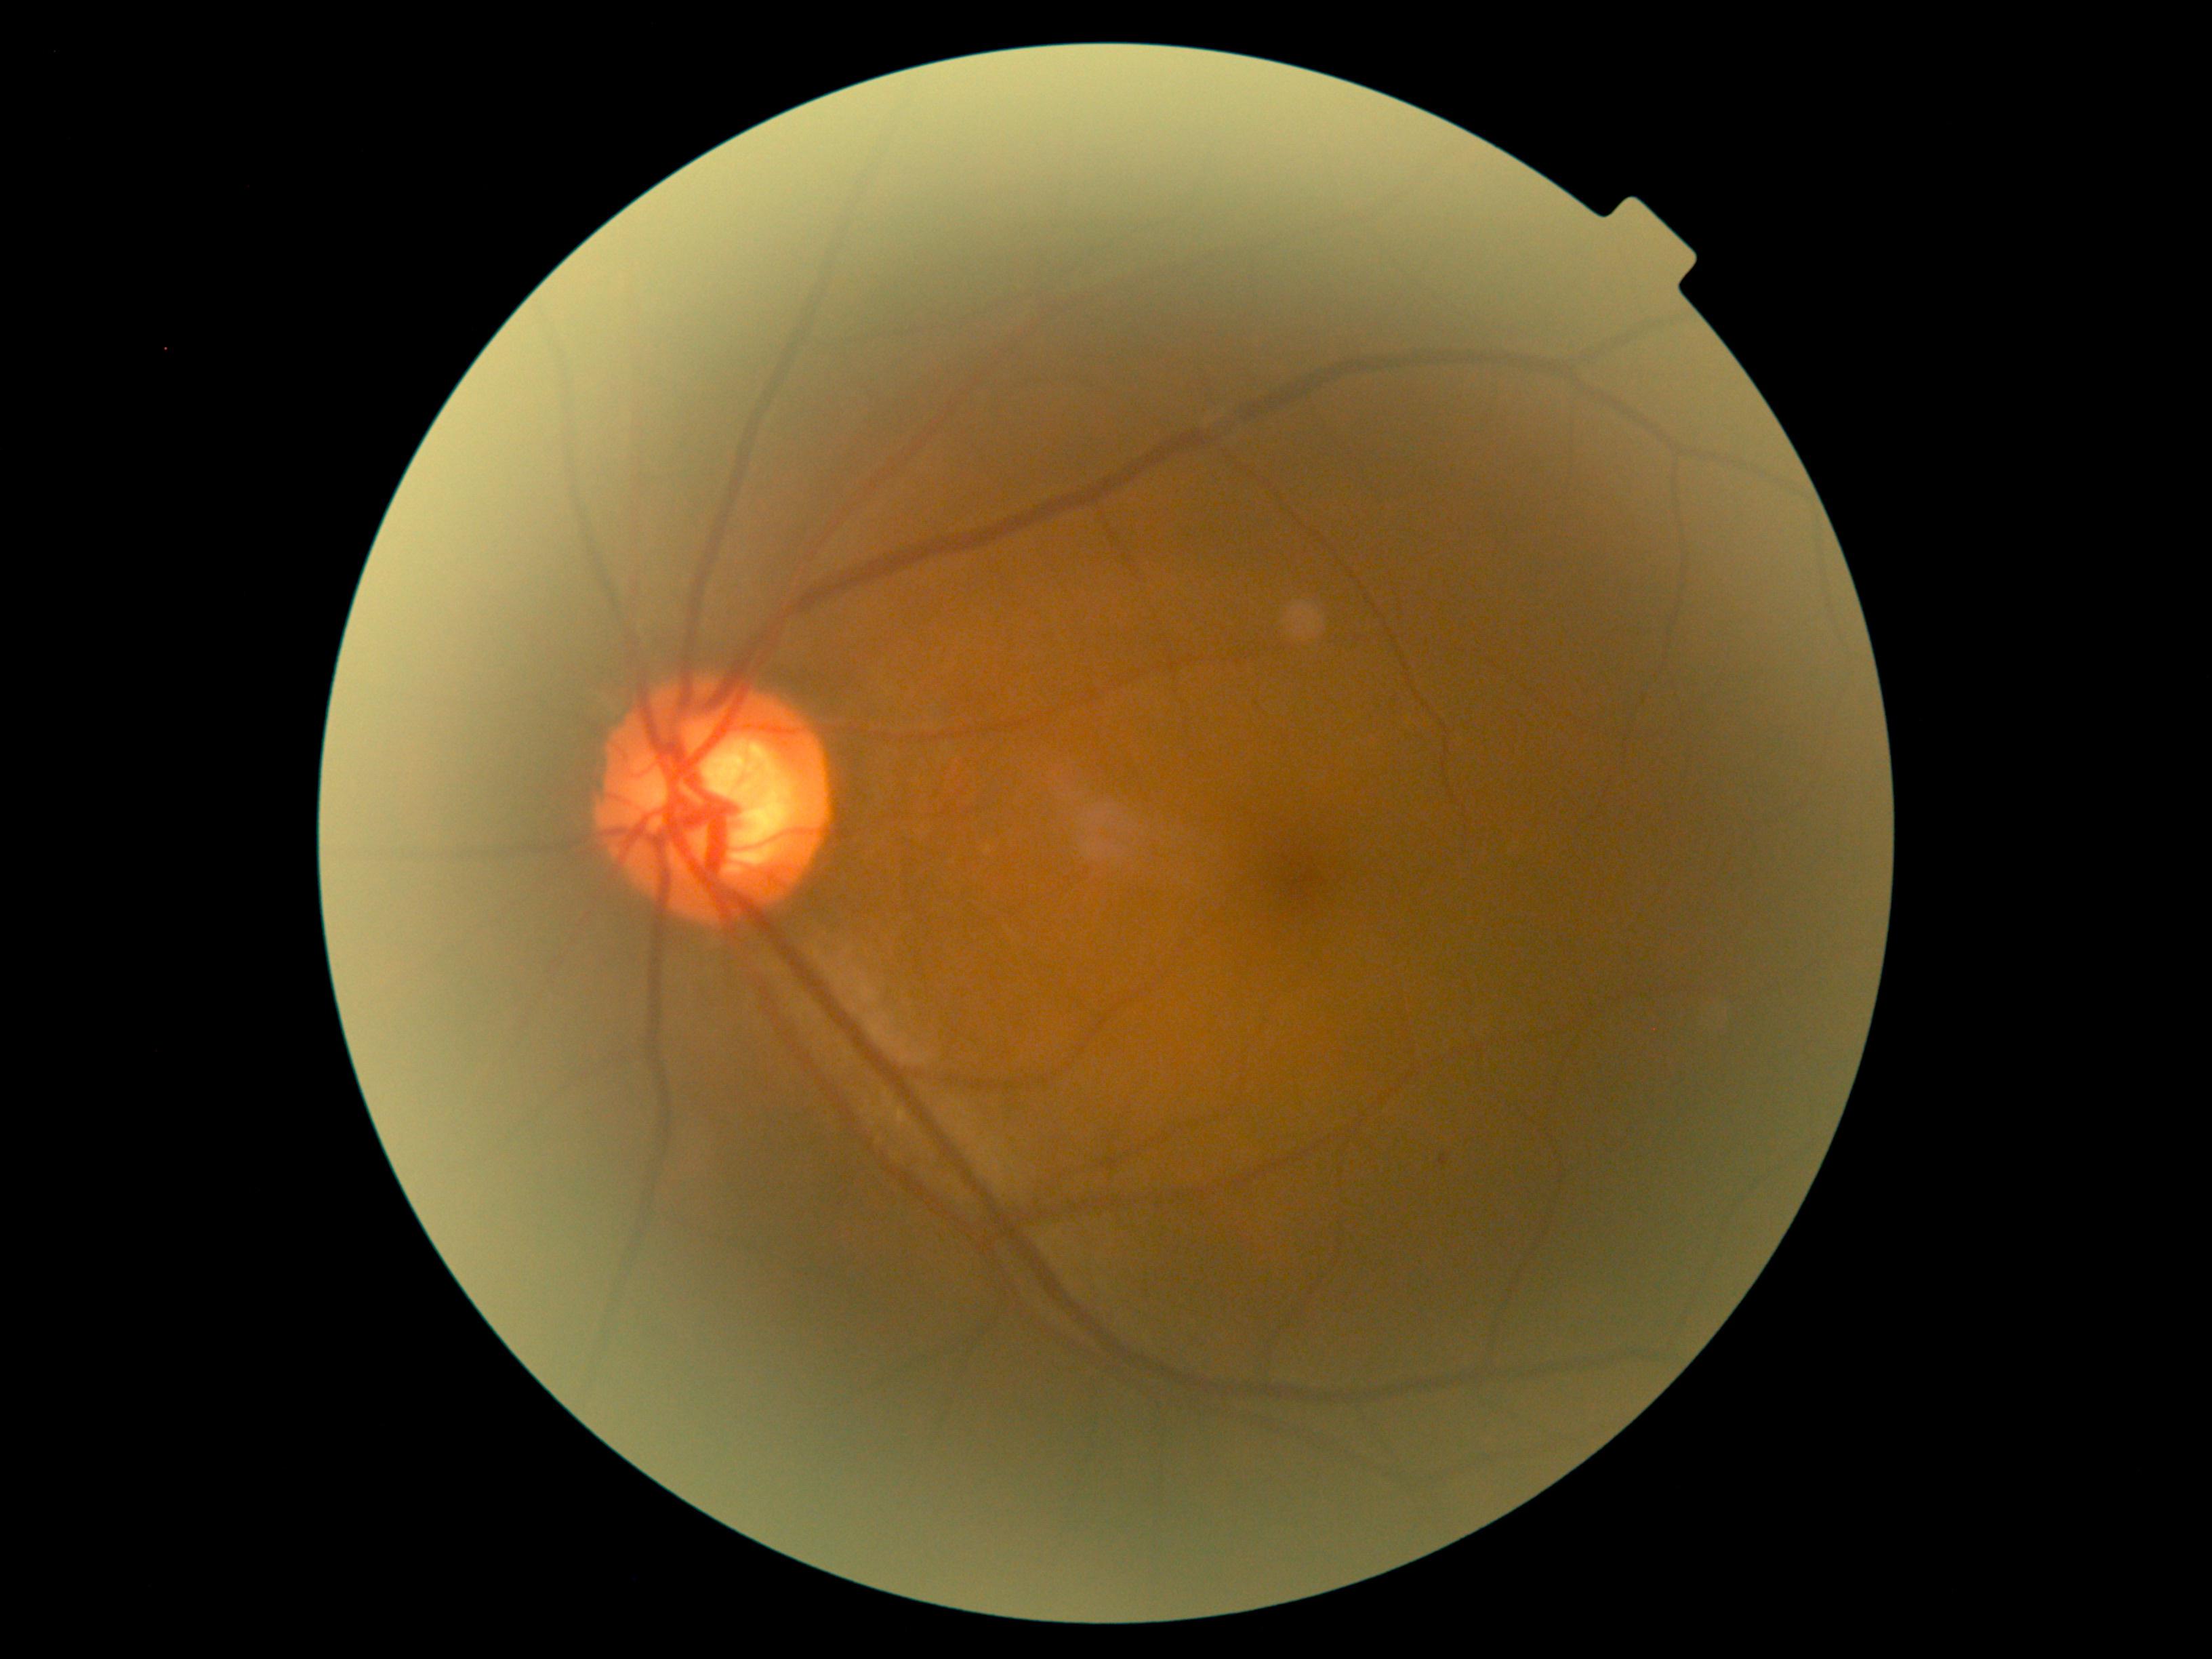
Findings:
• diabetic retinopathy (DR) — grade 1